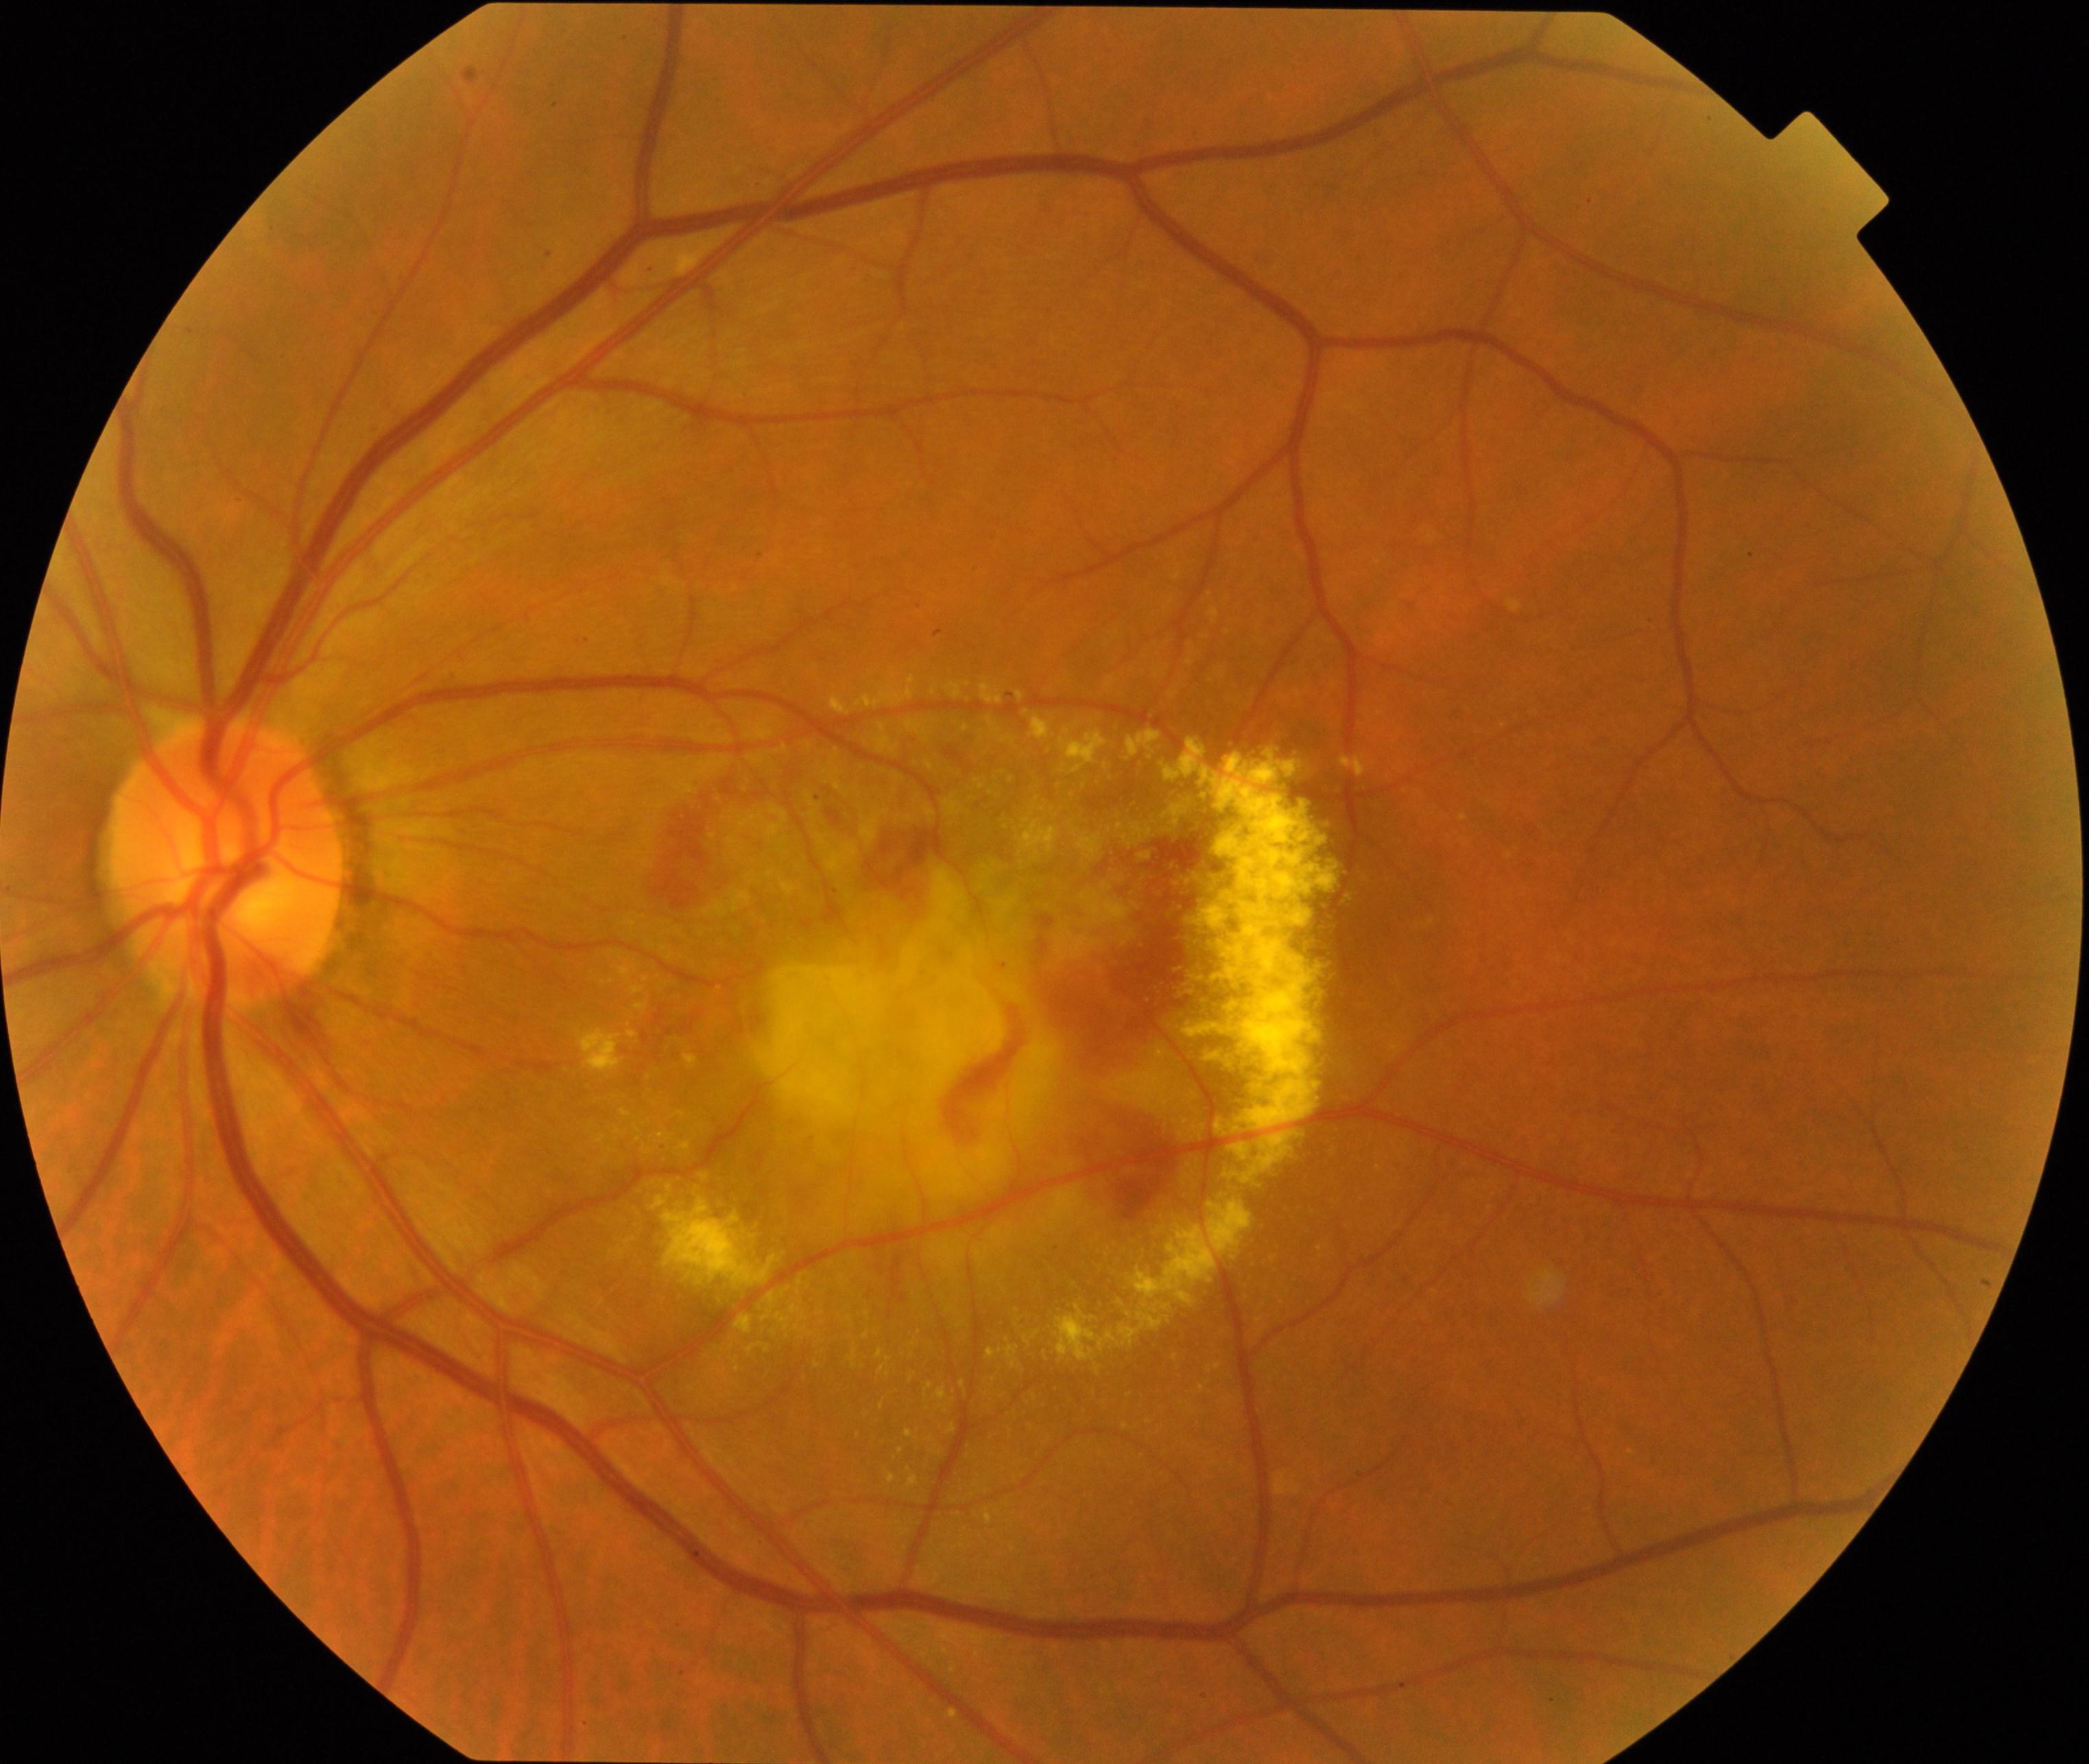

Consistent with maculopathy.